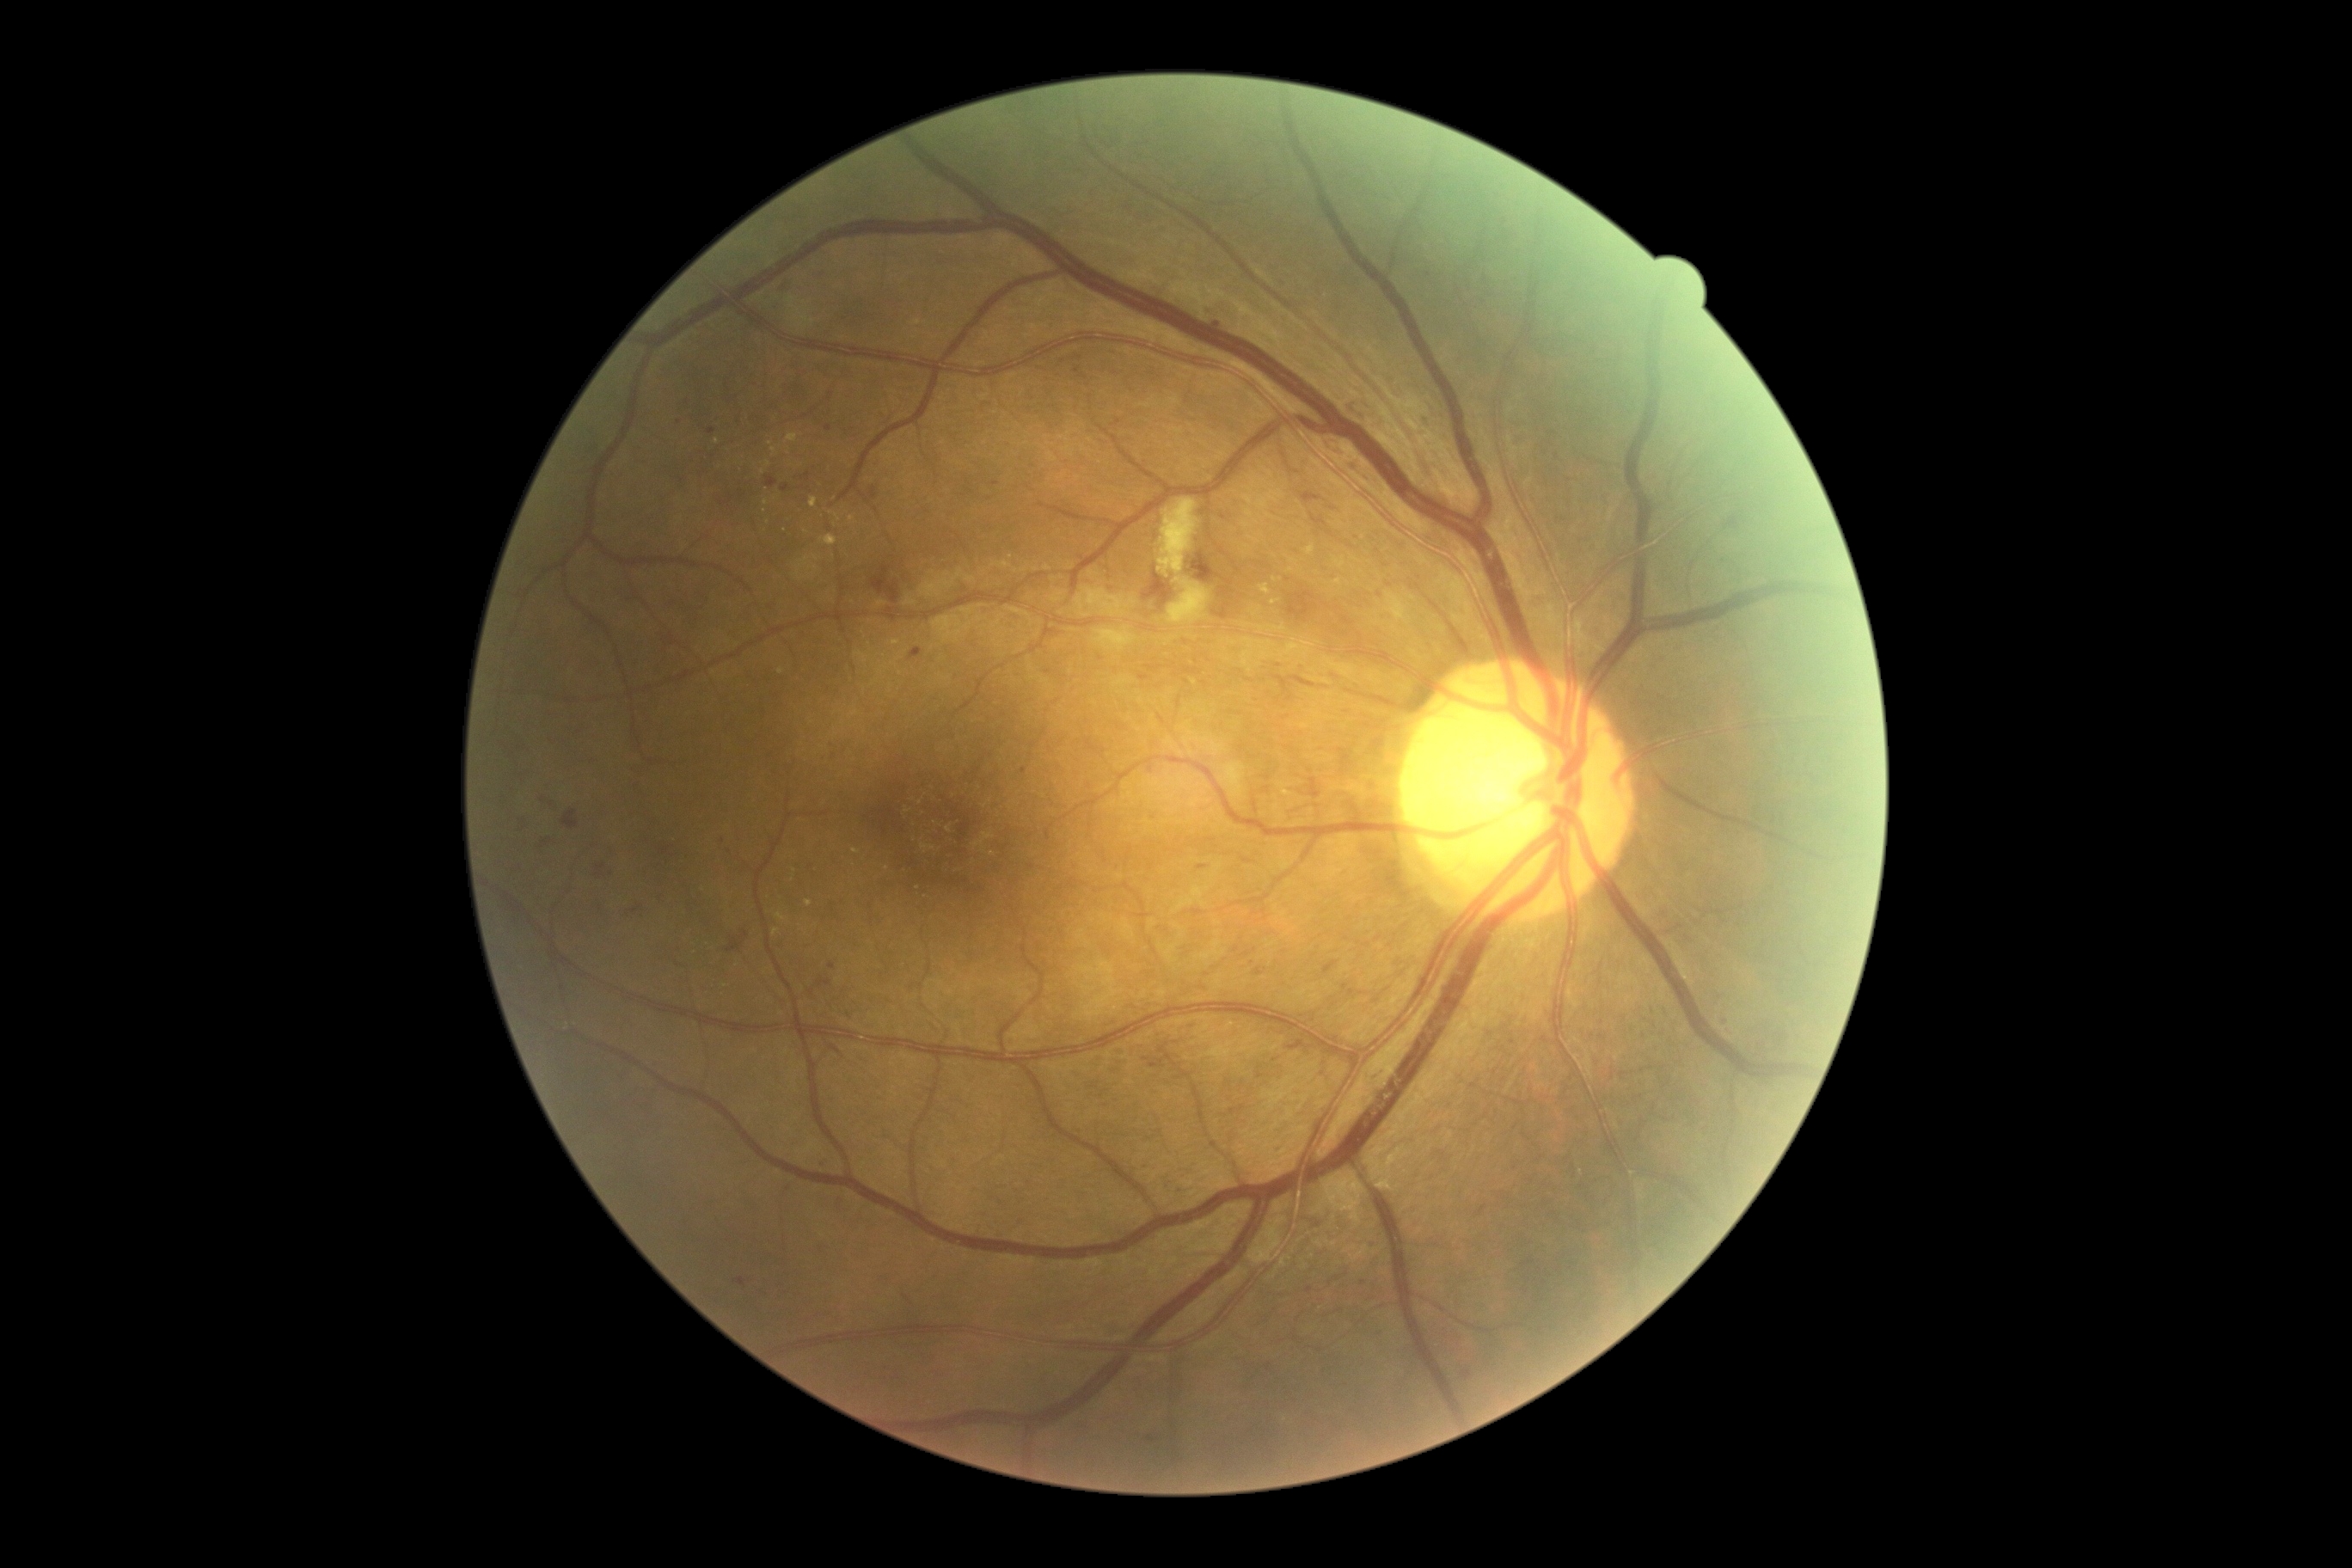 Diabetic retinopathy (DR): grade 2 (moderate NPDR) — more than just microaneurysms but less than severe NPDR. Microaneurysms (MAs) include (x1=909, y1=649, x2=922, y2=661); (x1=632, y1=907, x2=642, y2=914); (x1=1366, y1=1242, x2=1376, y2=1249); (x1=1074, y1=357, x2=1082, y2=360); (x1=1113, y1=420, x2=1122, y2=427); (x1=1197, y1=866, x2=1206, y2=871); (x1=1462, y1=1371, x2=1473, y2=1380); (x1=707, y1=429, x2=716, y2=436); (x1=1301, y1=493, x2=1321, y2=503); (x1=1050, y1=630, x2=1063, y2=639). Small MAs approximately at [x=1048, y=673]; [x=551, y=805]; [x=1063, y=362]; [x=1557, y=457]; [x=1330, y=534]; [x=1426, y=425]; [x=666, y=851]. Hard exudates (EXs) include (x1=830, y1=511, x2=842, y2=522); (x1=809, y1=498, x2=818, y2=508); (x1=1335, y1=558, x2=1345, y2=568); (x1=1306, y1=546, x2=1314, y2=554); (x1=795, y1=556, x2=819, y2=580); (x1=852, y1=848, x2=861, y2=855); (x1=785, y1=434, x2=799, y2=444); (x1=821, y1=536, x2=838, y2=548). Small EXs approximately at [x=1293, y=561]; [x=896, y=643]; [x=1291, y=570]; [x=774, y=451]; [x=1338, y=582]; [x=768, y=463]; [x=805, y=532]; [x=907, y=811]; [x=1275, y=581]; [x=771, y=444]; [x=717, y=441].